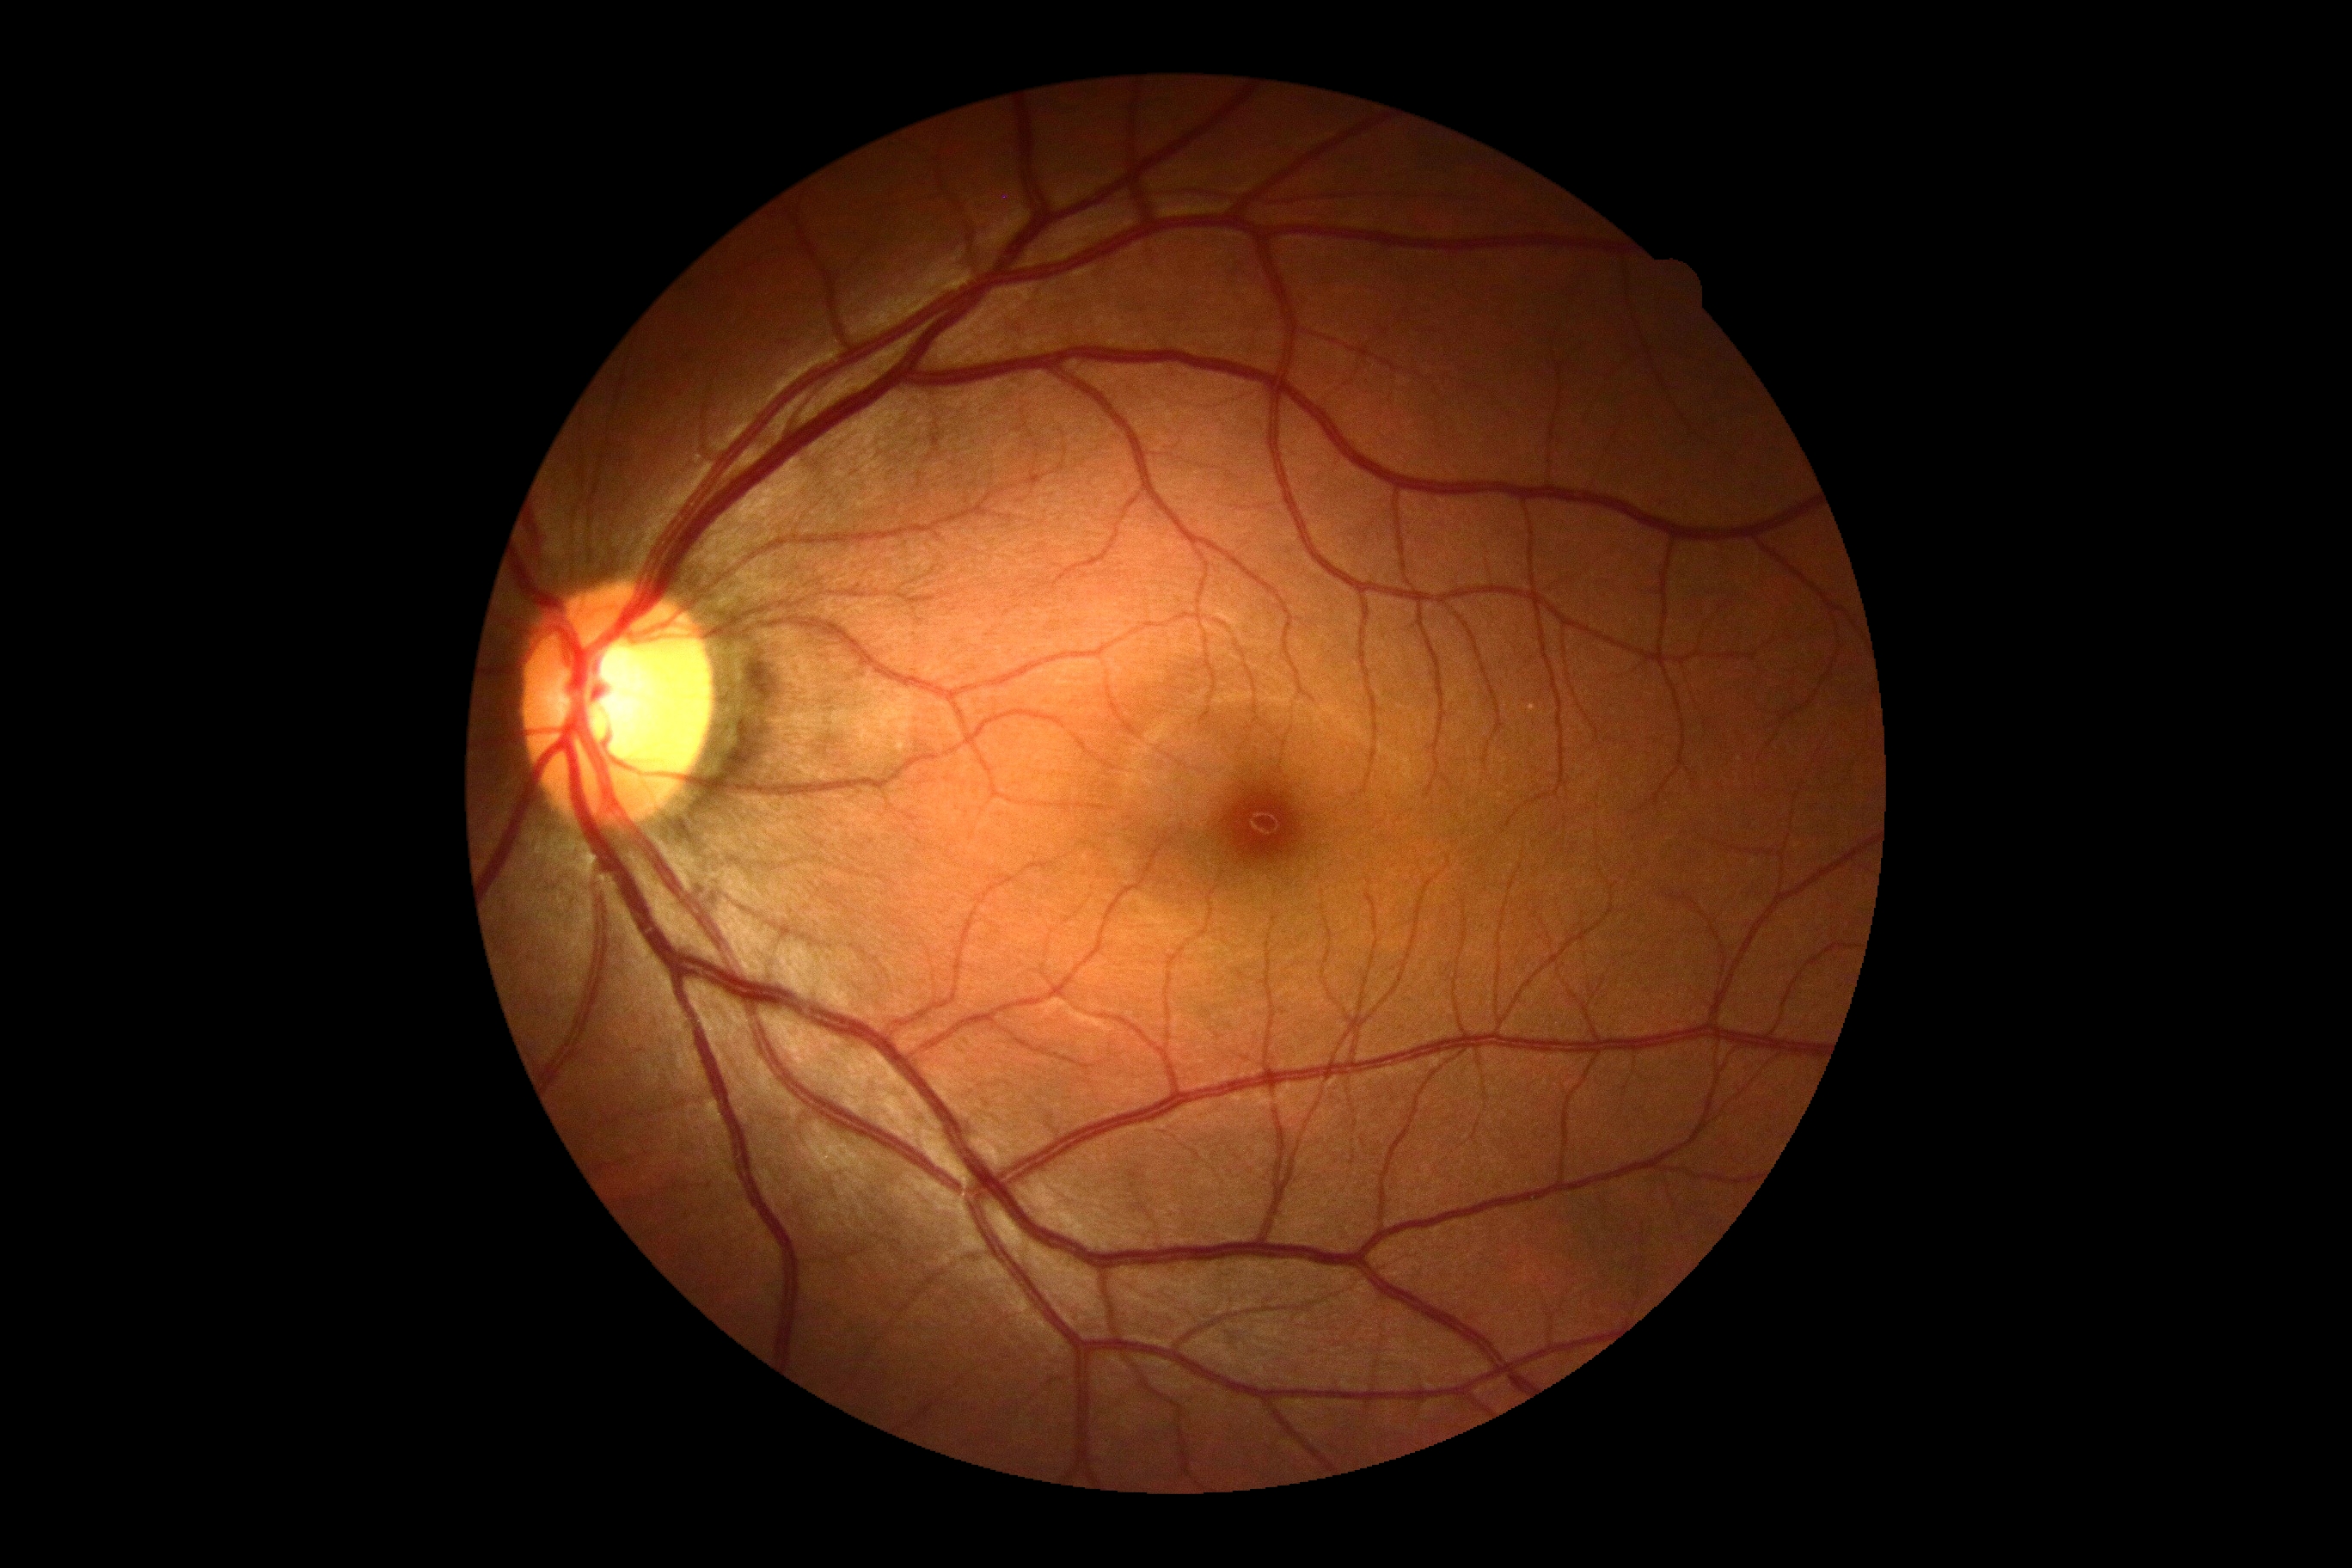 No apparent diabetic retinopathy. Diabetic retinopathy: no apparent diabetic retinopathy (grade 0).